848x848, NIDEK AFC-230: 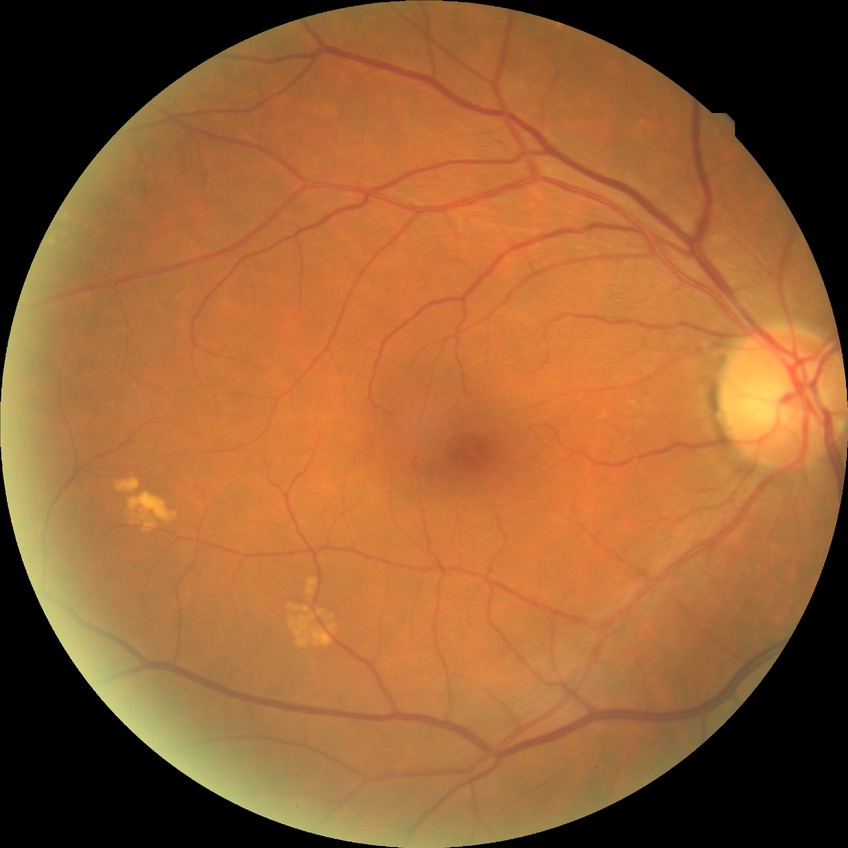
Davis grading: no diabetic retinopathy.